Captured on a Canon CR-1 fundus camera · image size 2352x1568 · retinal fundus photograph
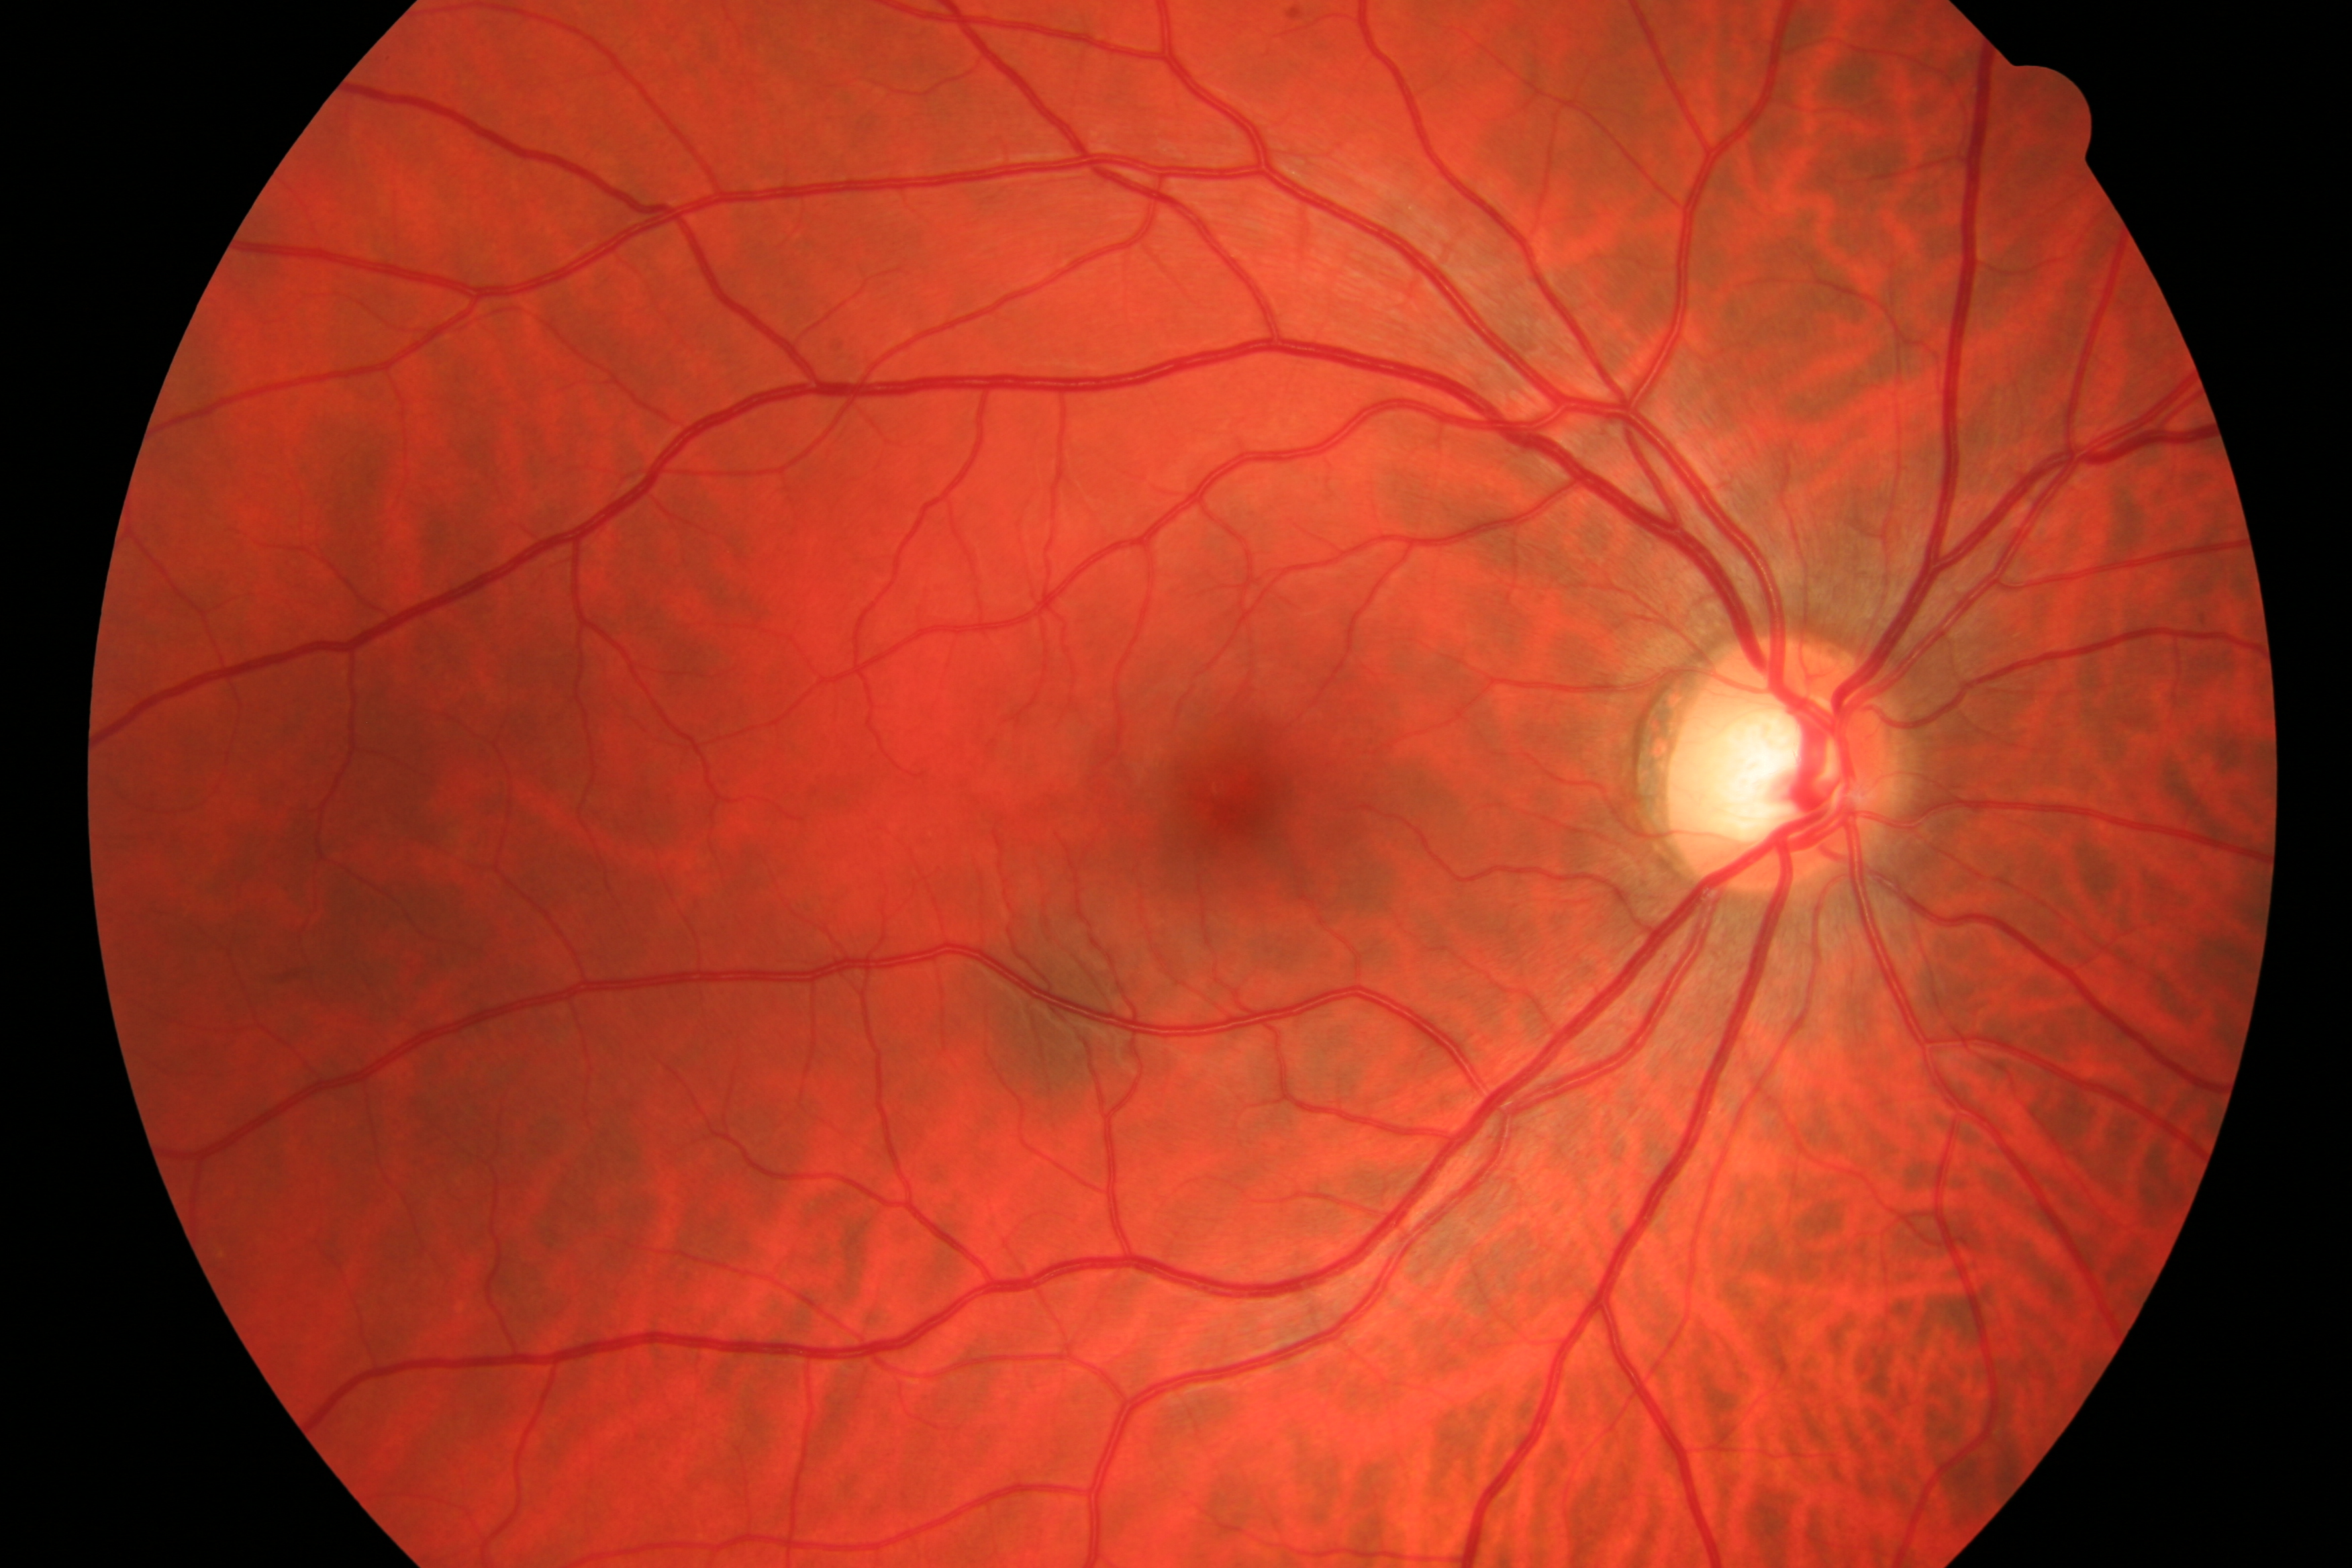

Pathology: no diabetic retinopathy or glaucoma.